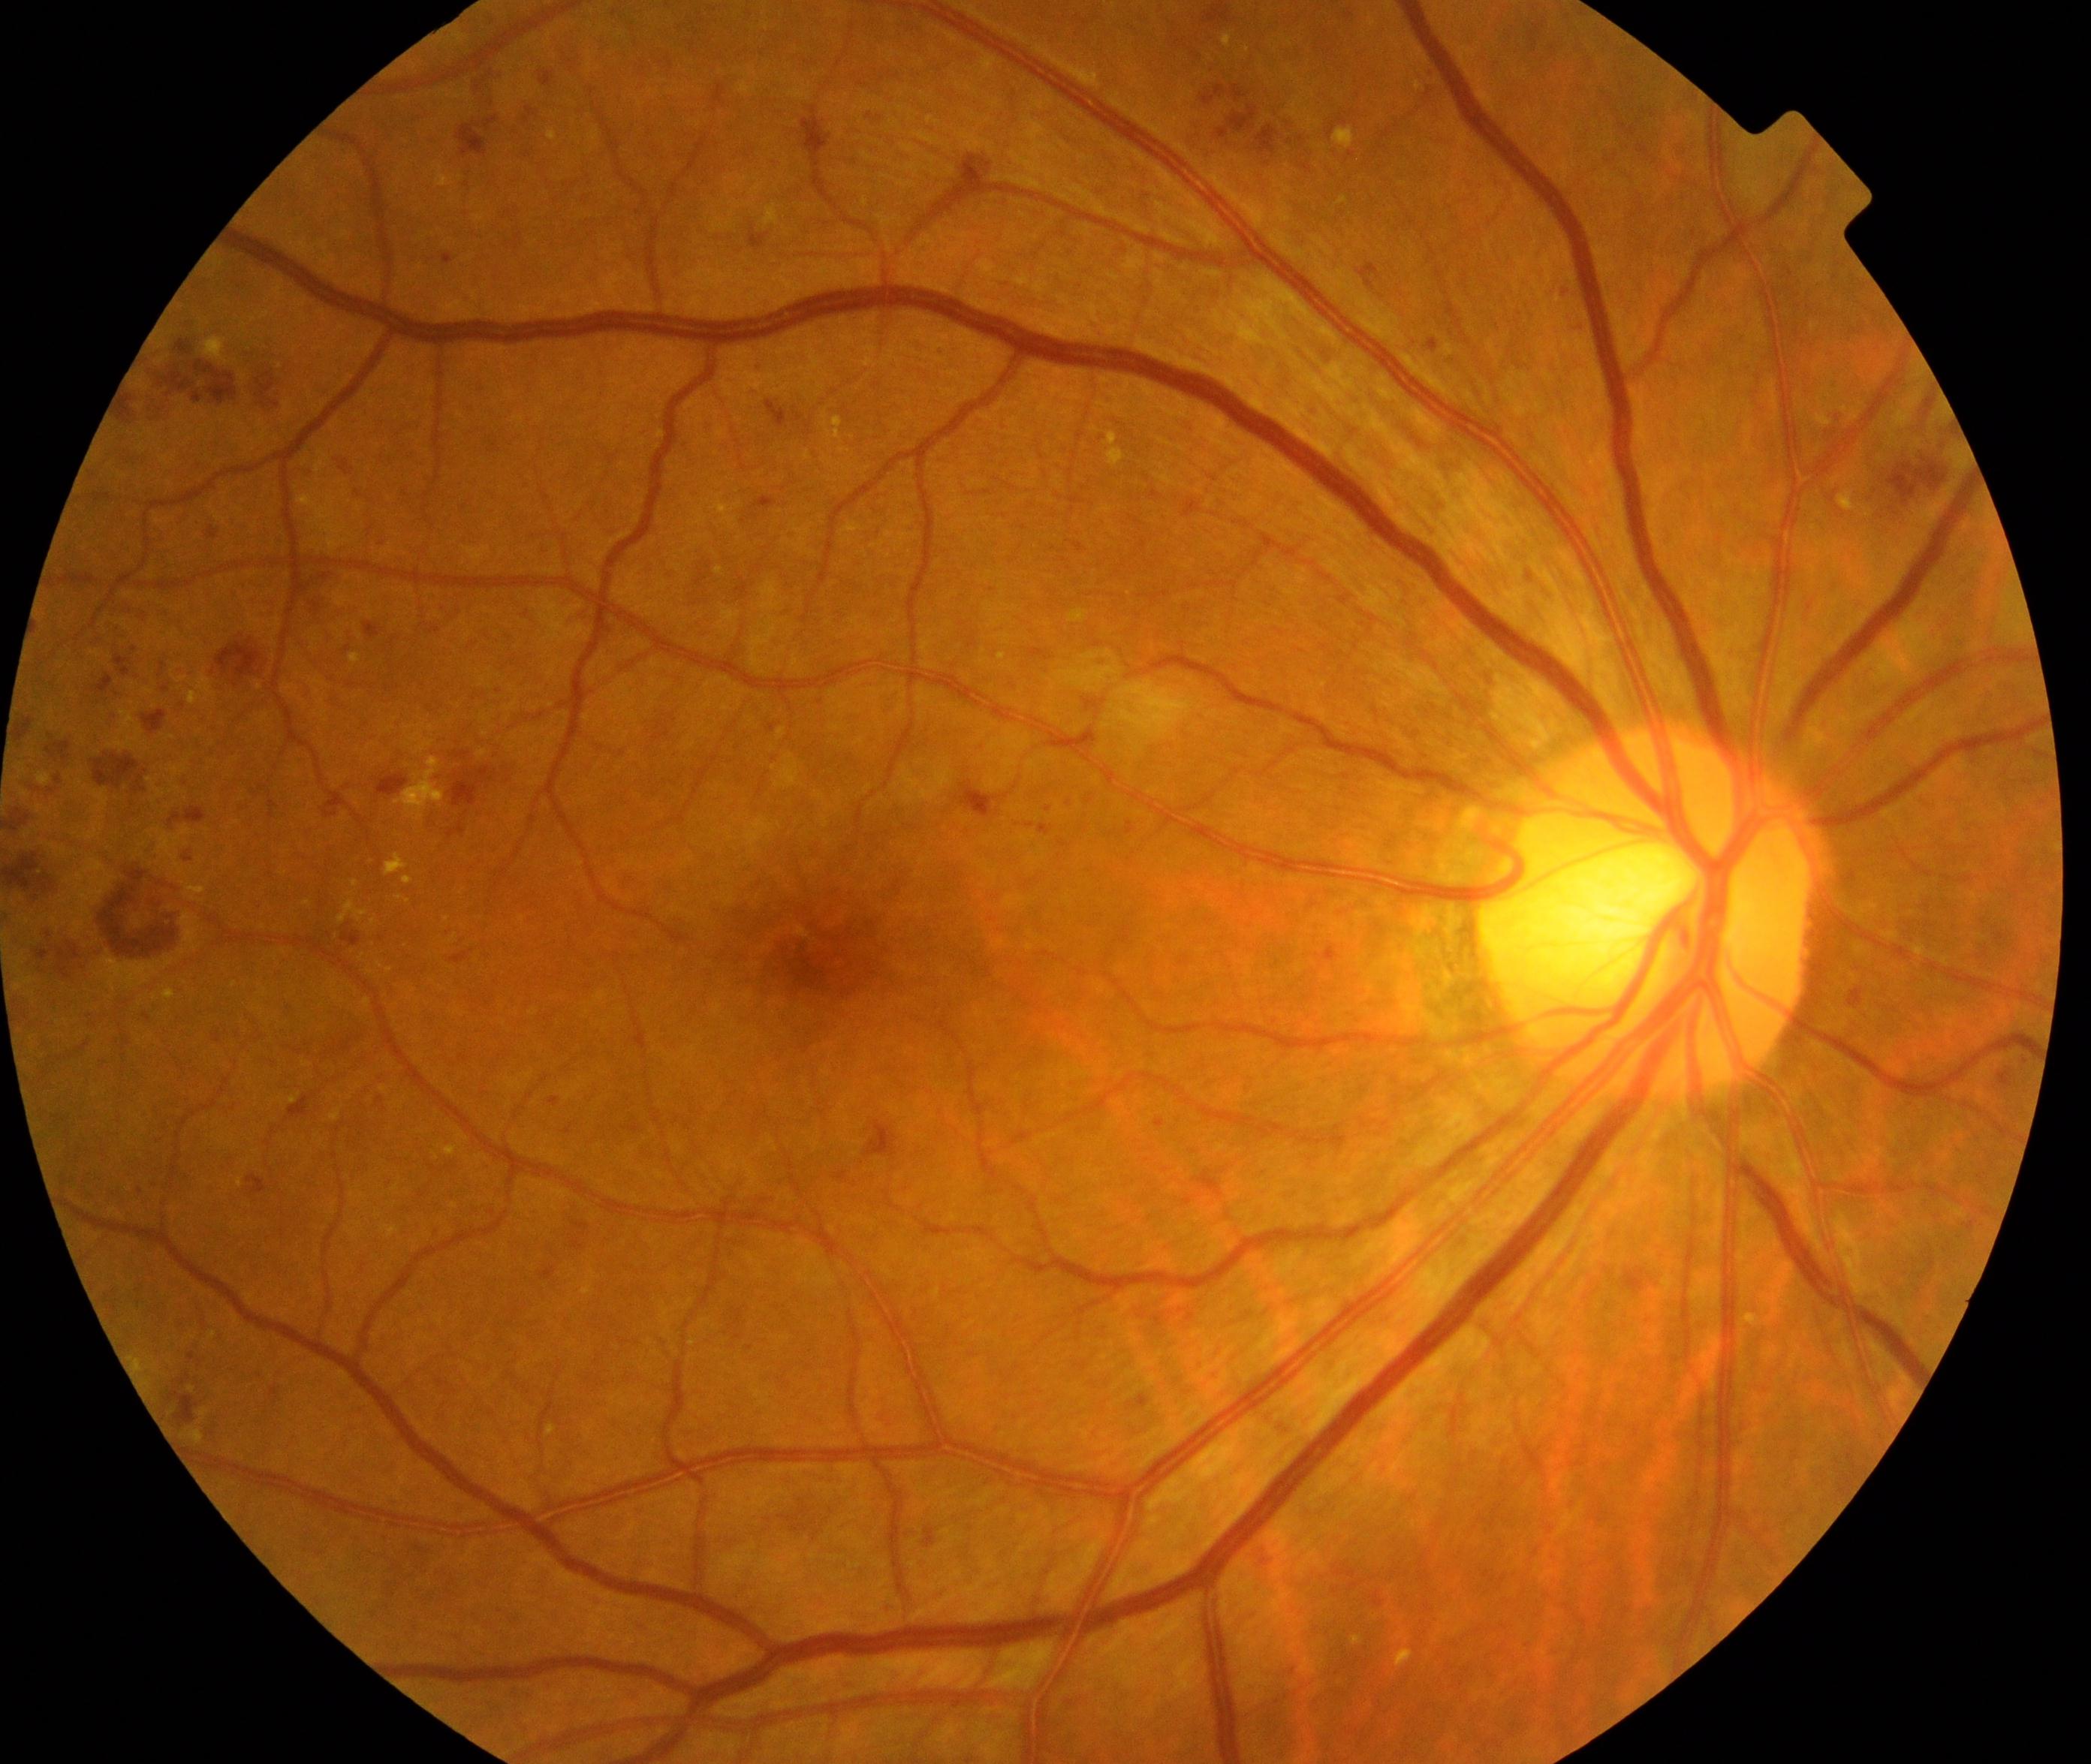
Impression: moderate non-proliferative diabetic retinopathy. Characterized by microaneurysms with dot and blot hemorrhages or hard exudates, less than severe non-proliferative diabetic retinopathy, and/or with diabetic macular edema.